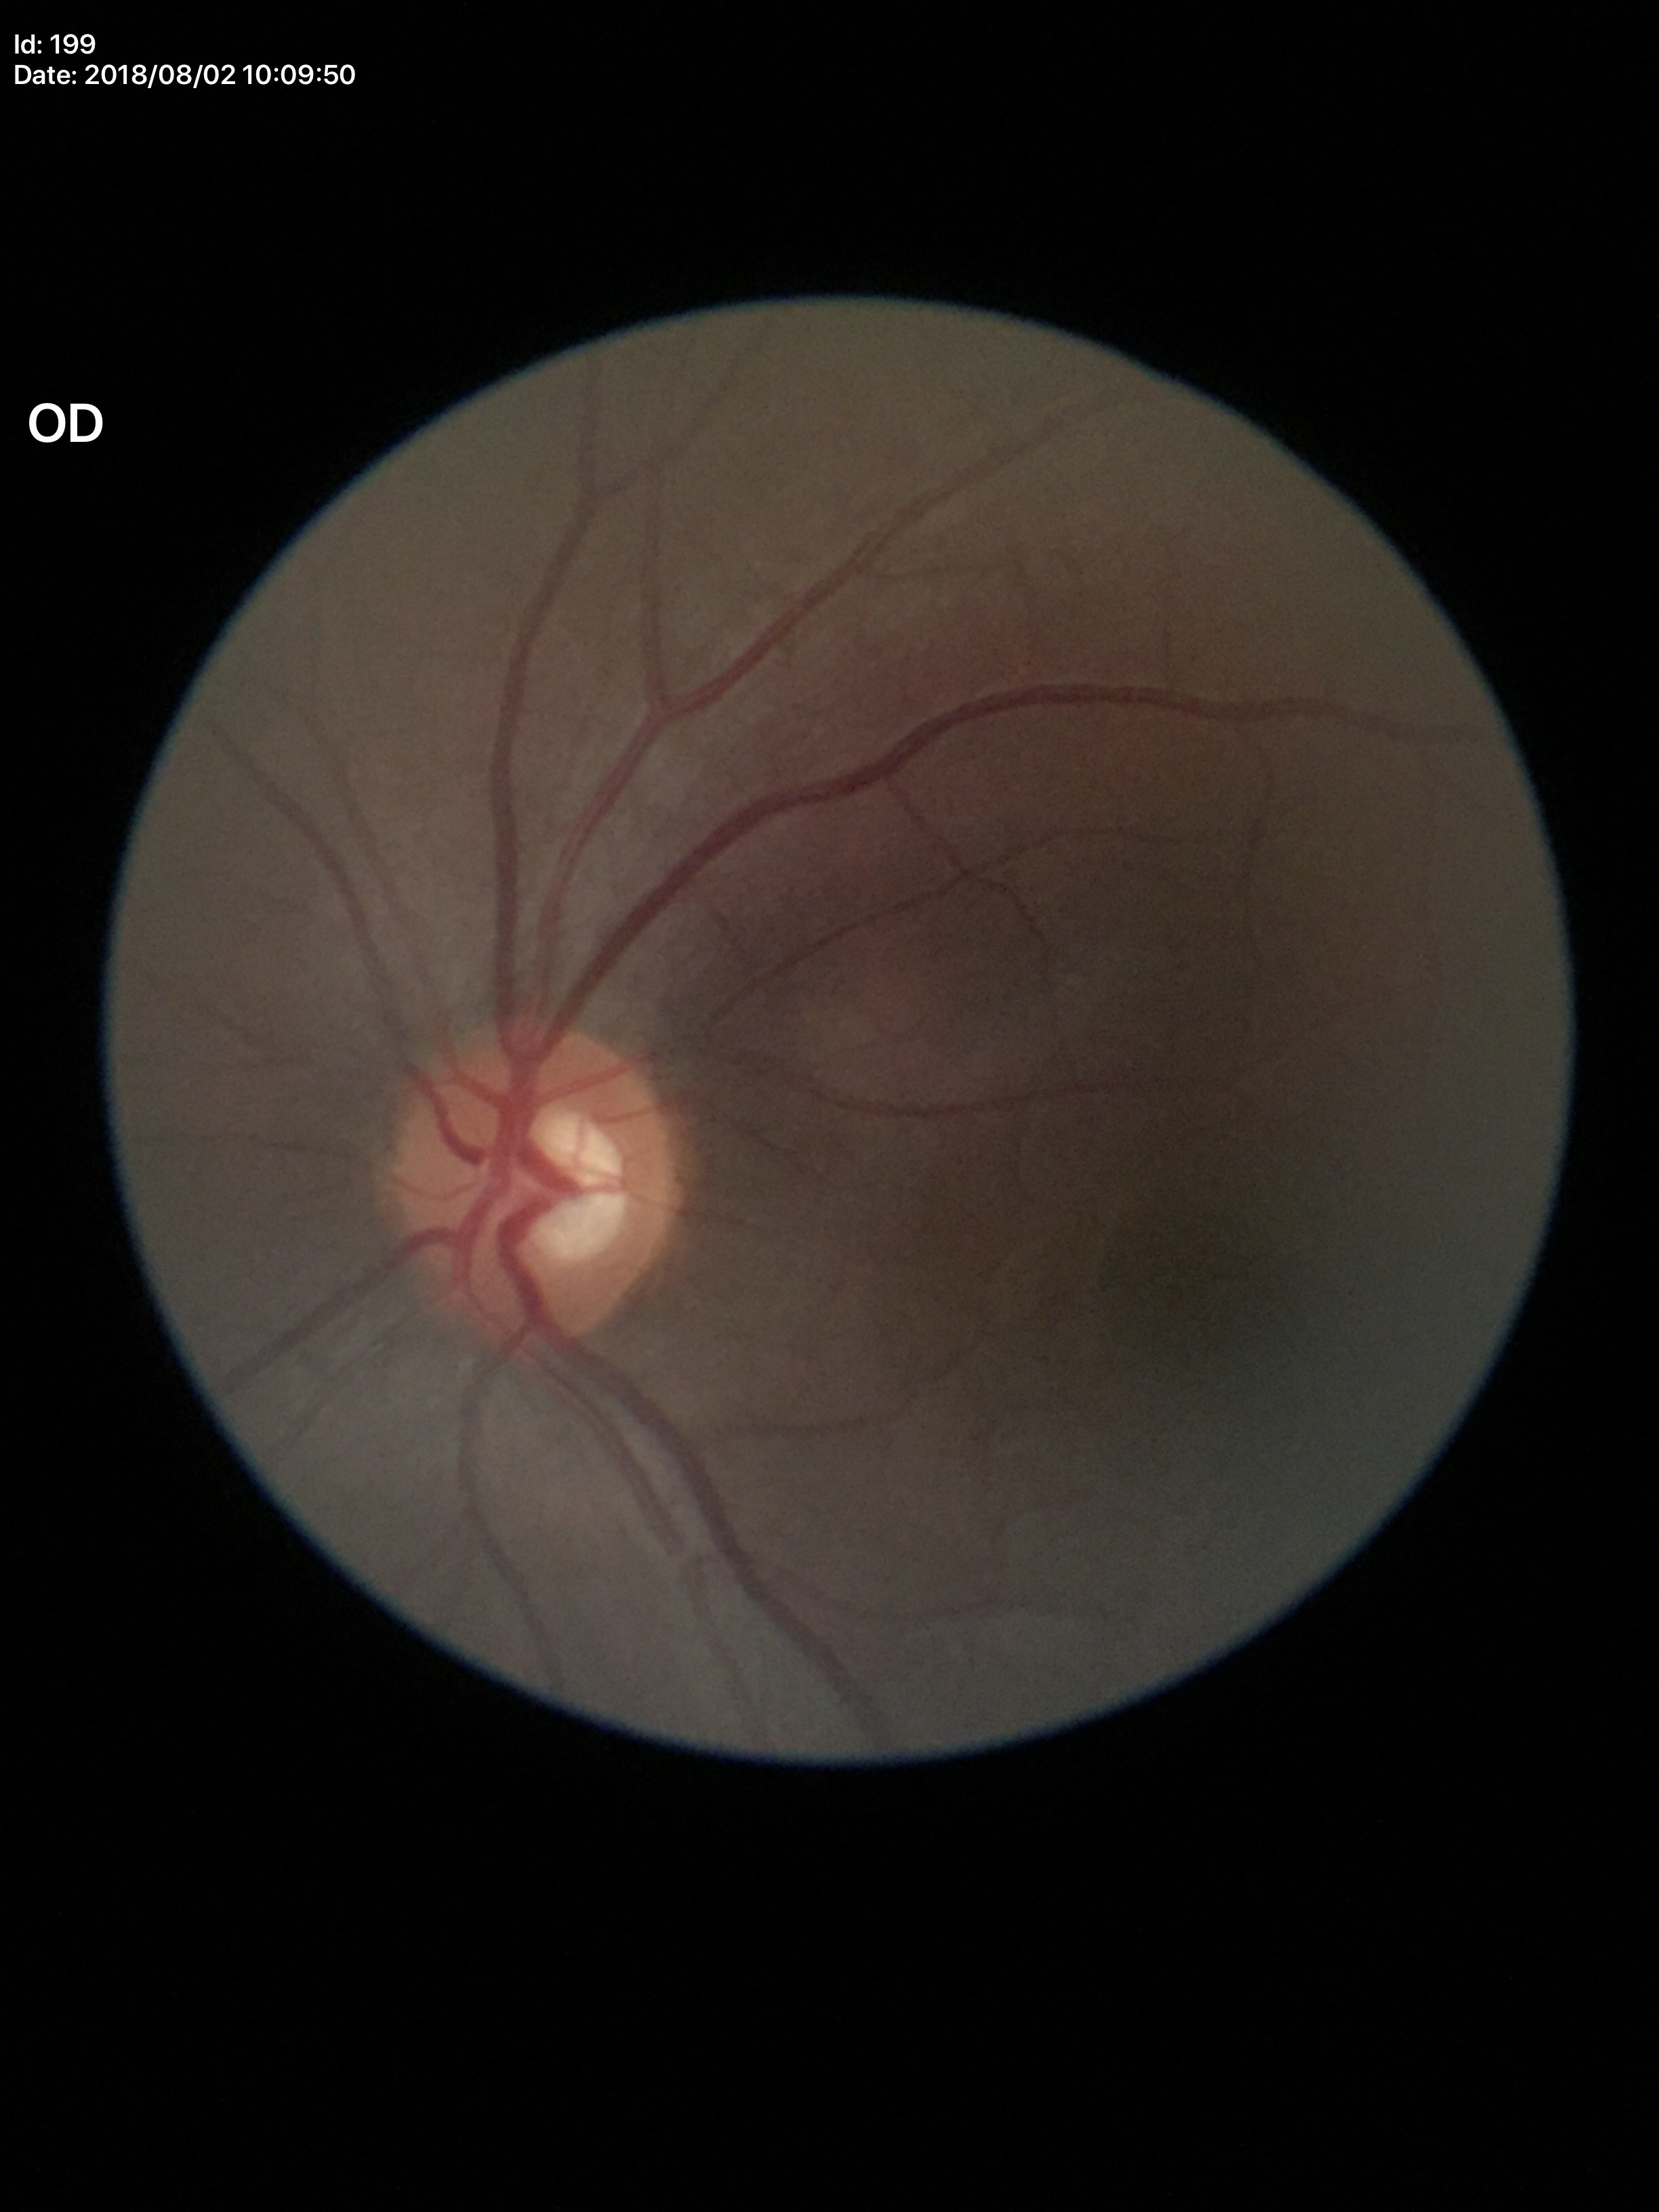

Glaucoma impression = not suspect
vertical CDR (VCDR) = 0.52